Diabetic retinopathy graded by the modified Davis classification · nonmydriatic · camera: NIDEK AFC-230 · CFP · 45 degree fundus photograph · image size 848x848 — 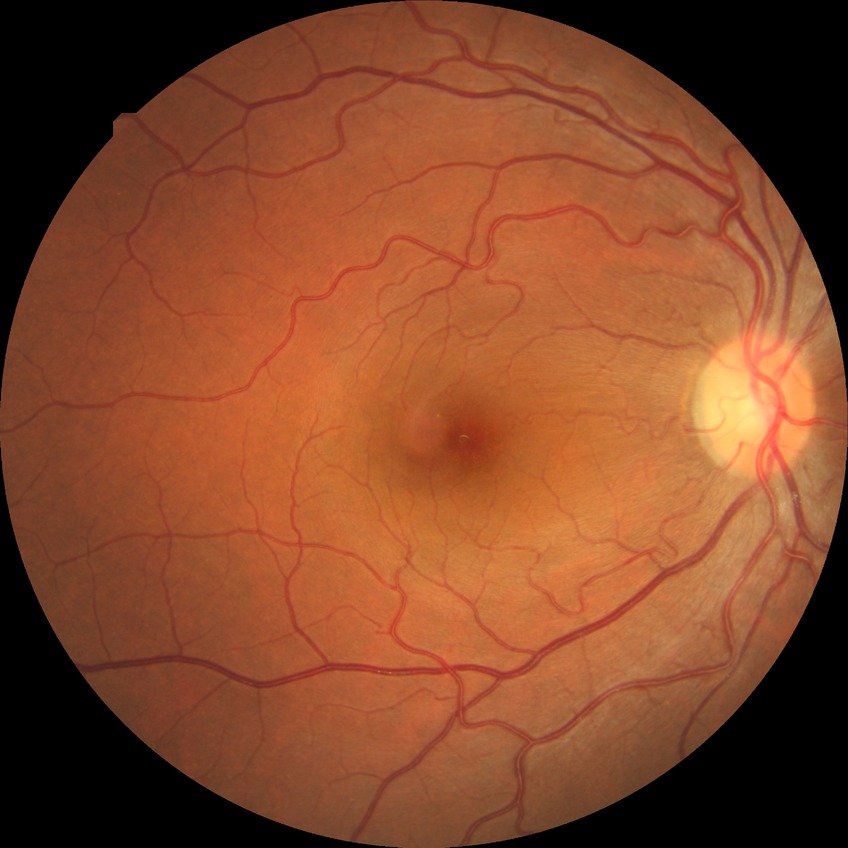 Diabetic retinopathy (DR): NDR (no diabetic retinopathy).